45° FOV — 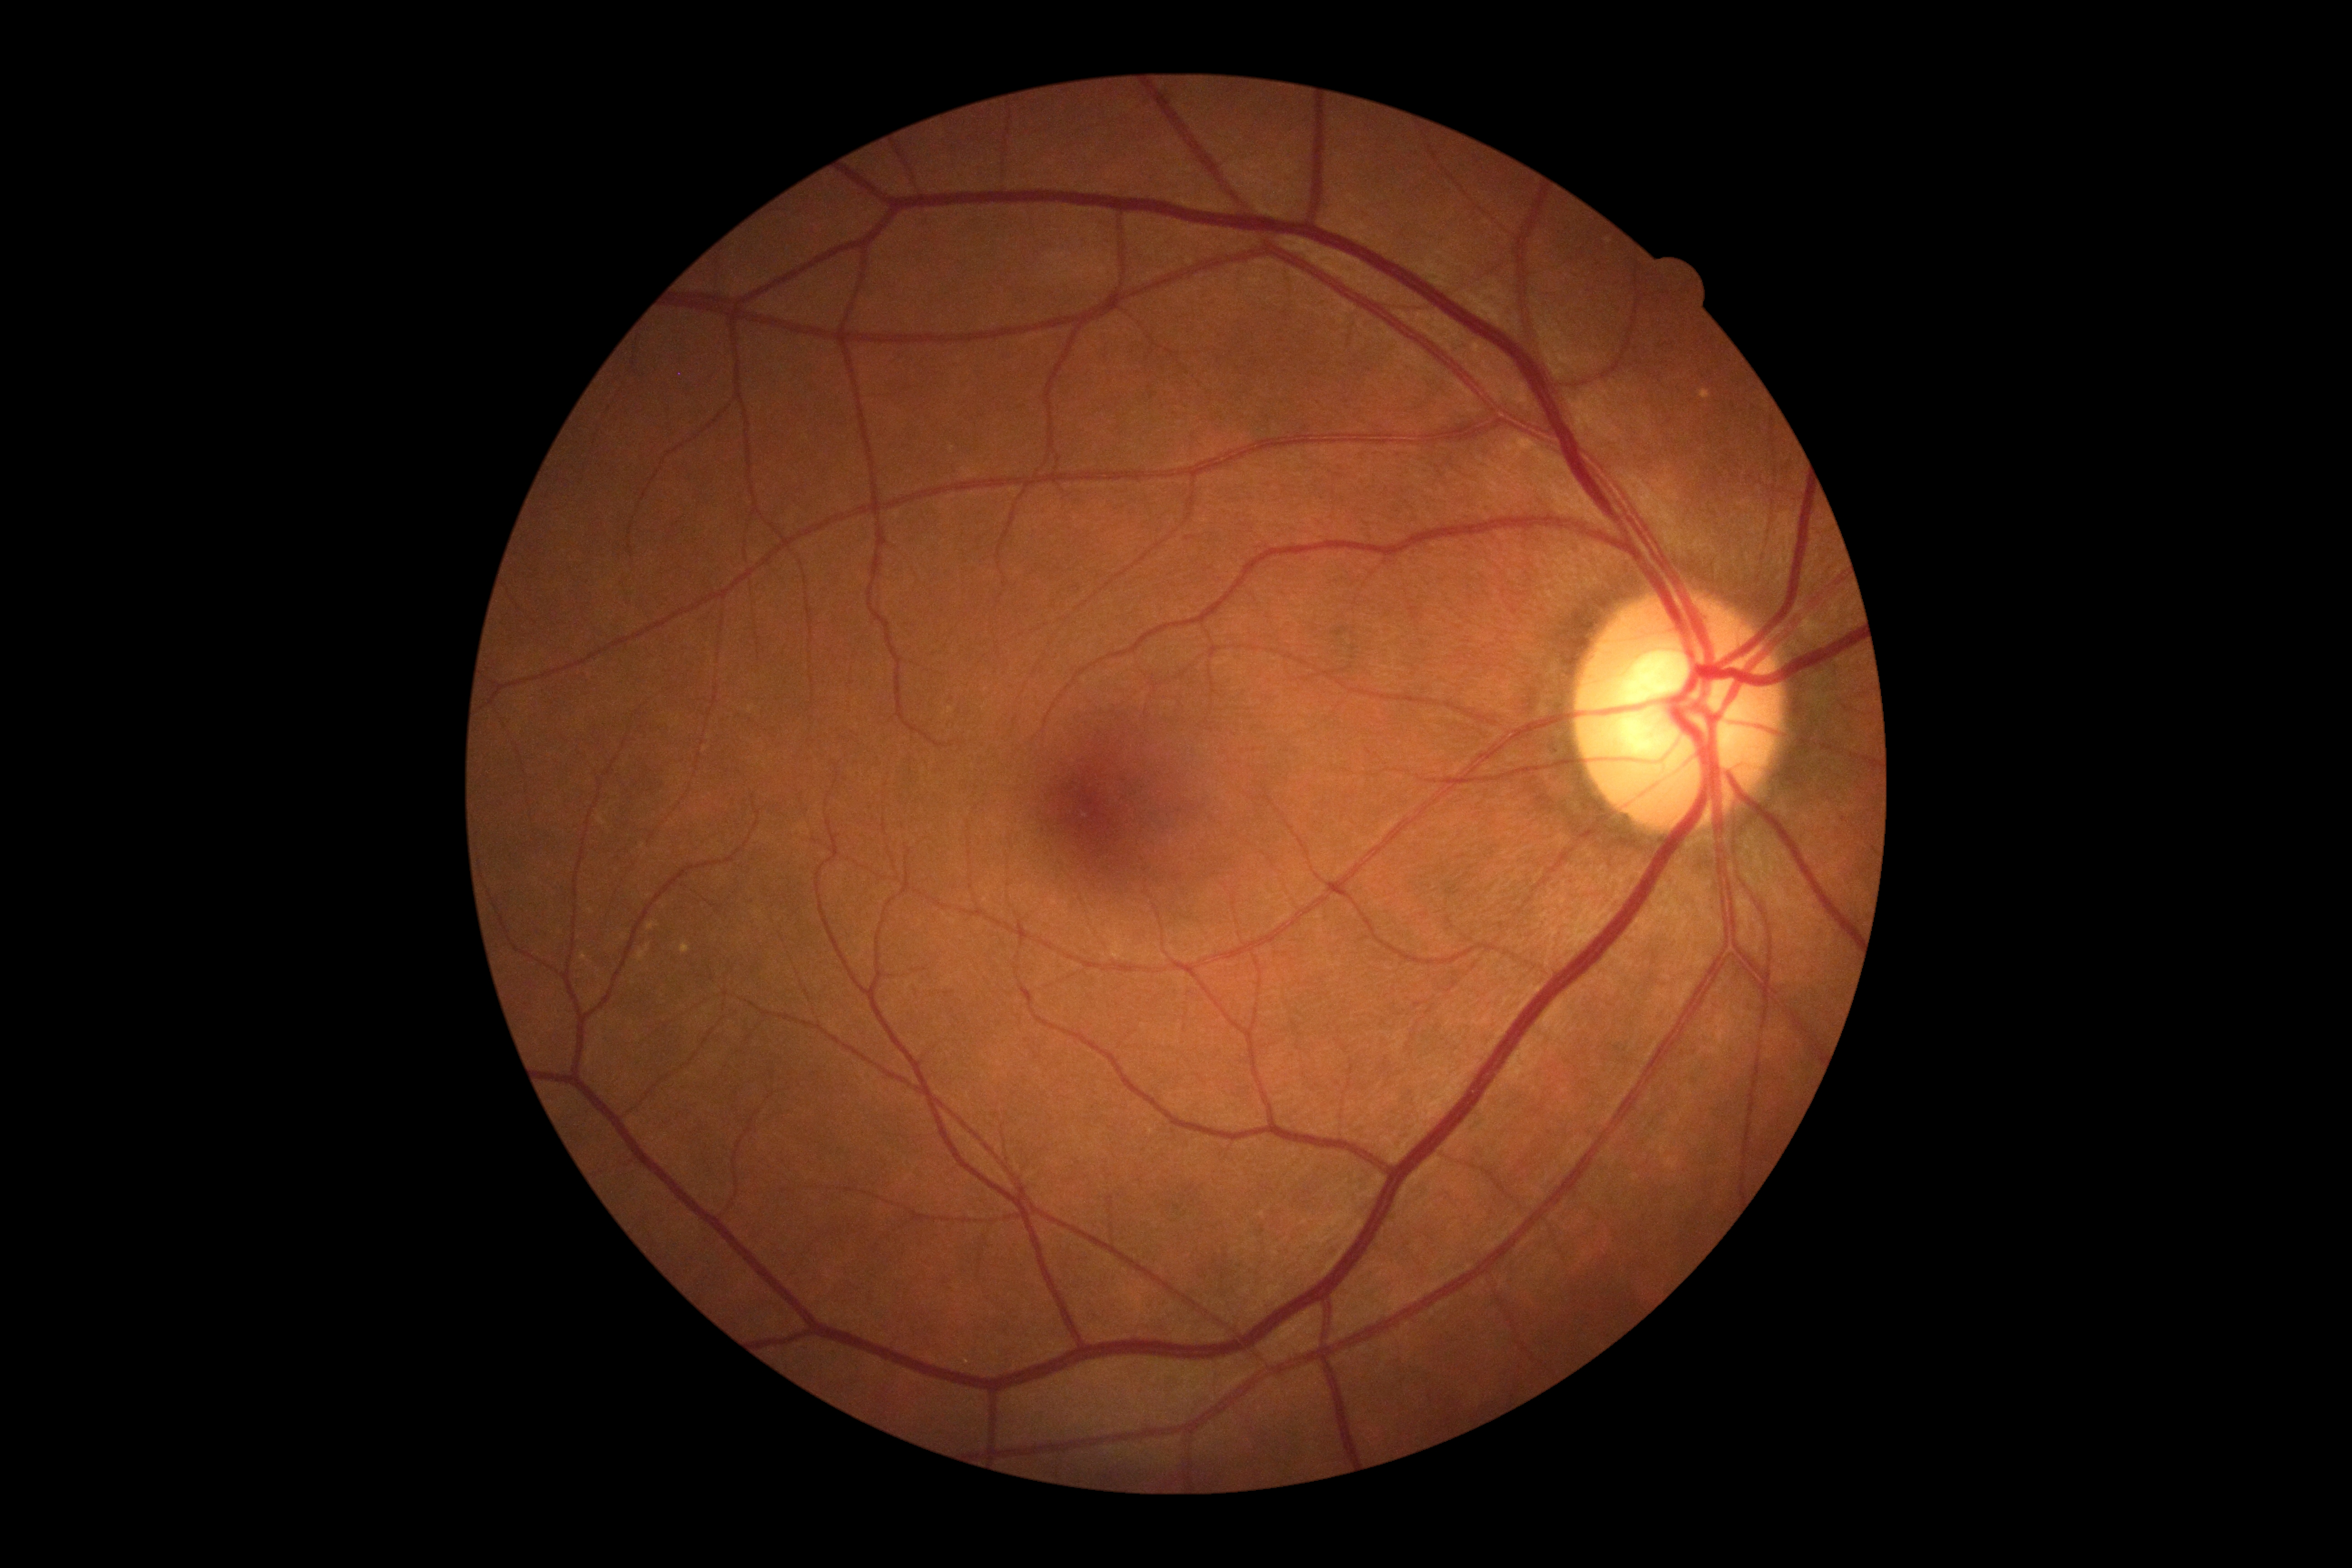
Annotations:
* DR impression — no signs of DR
* retinopathy — 0